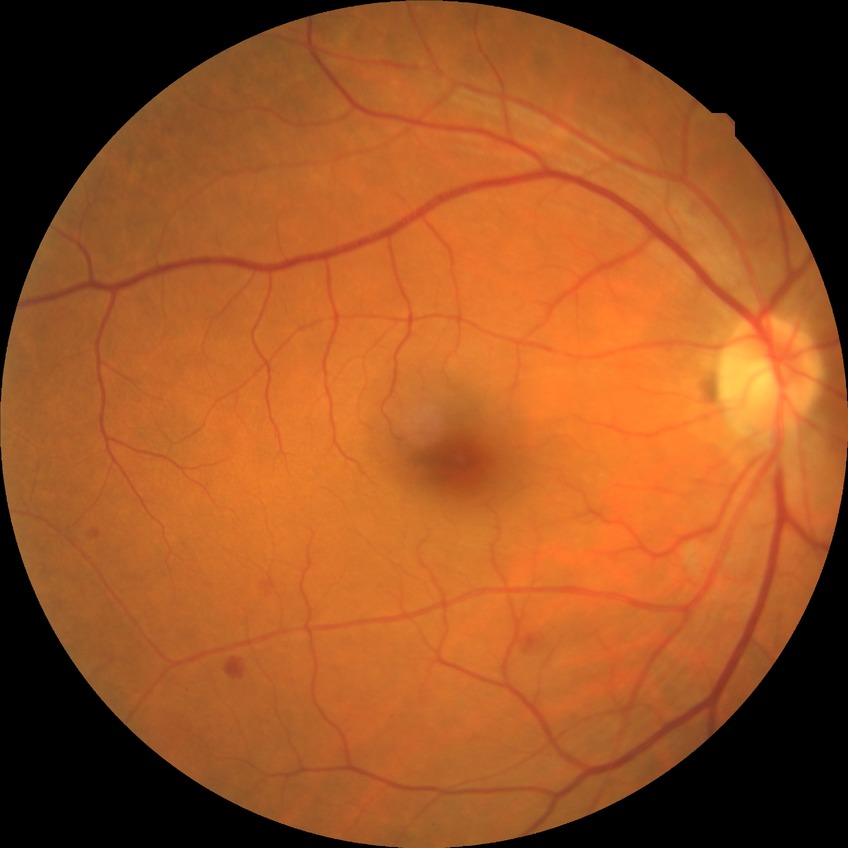 Diabetic retinopathy (DR) is SDR (simple diabetic retinopathy).